Disc-centered field: 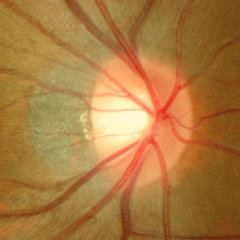
Showing no signs of glaucoma.